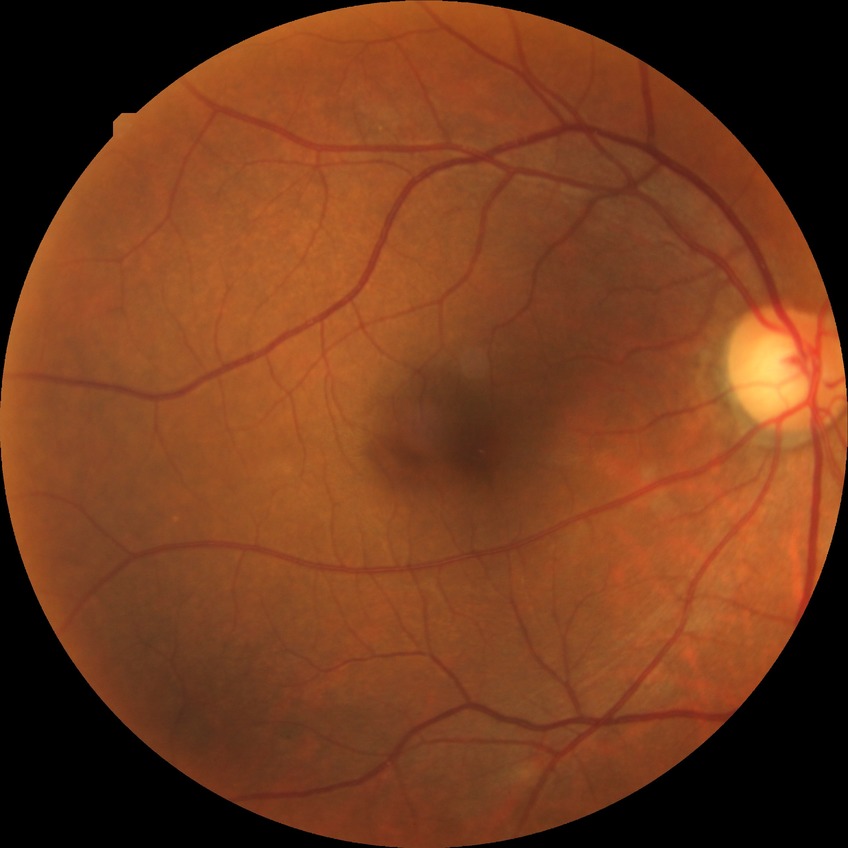

Modified Davis grade: NDR.